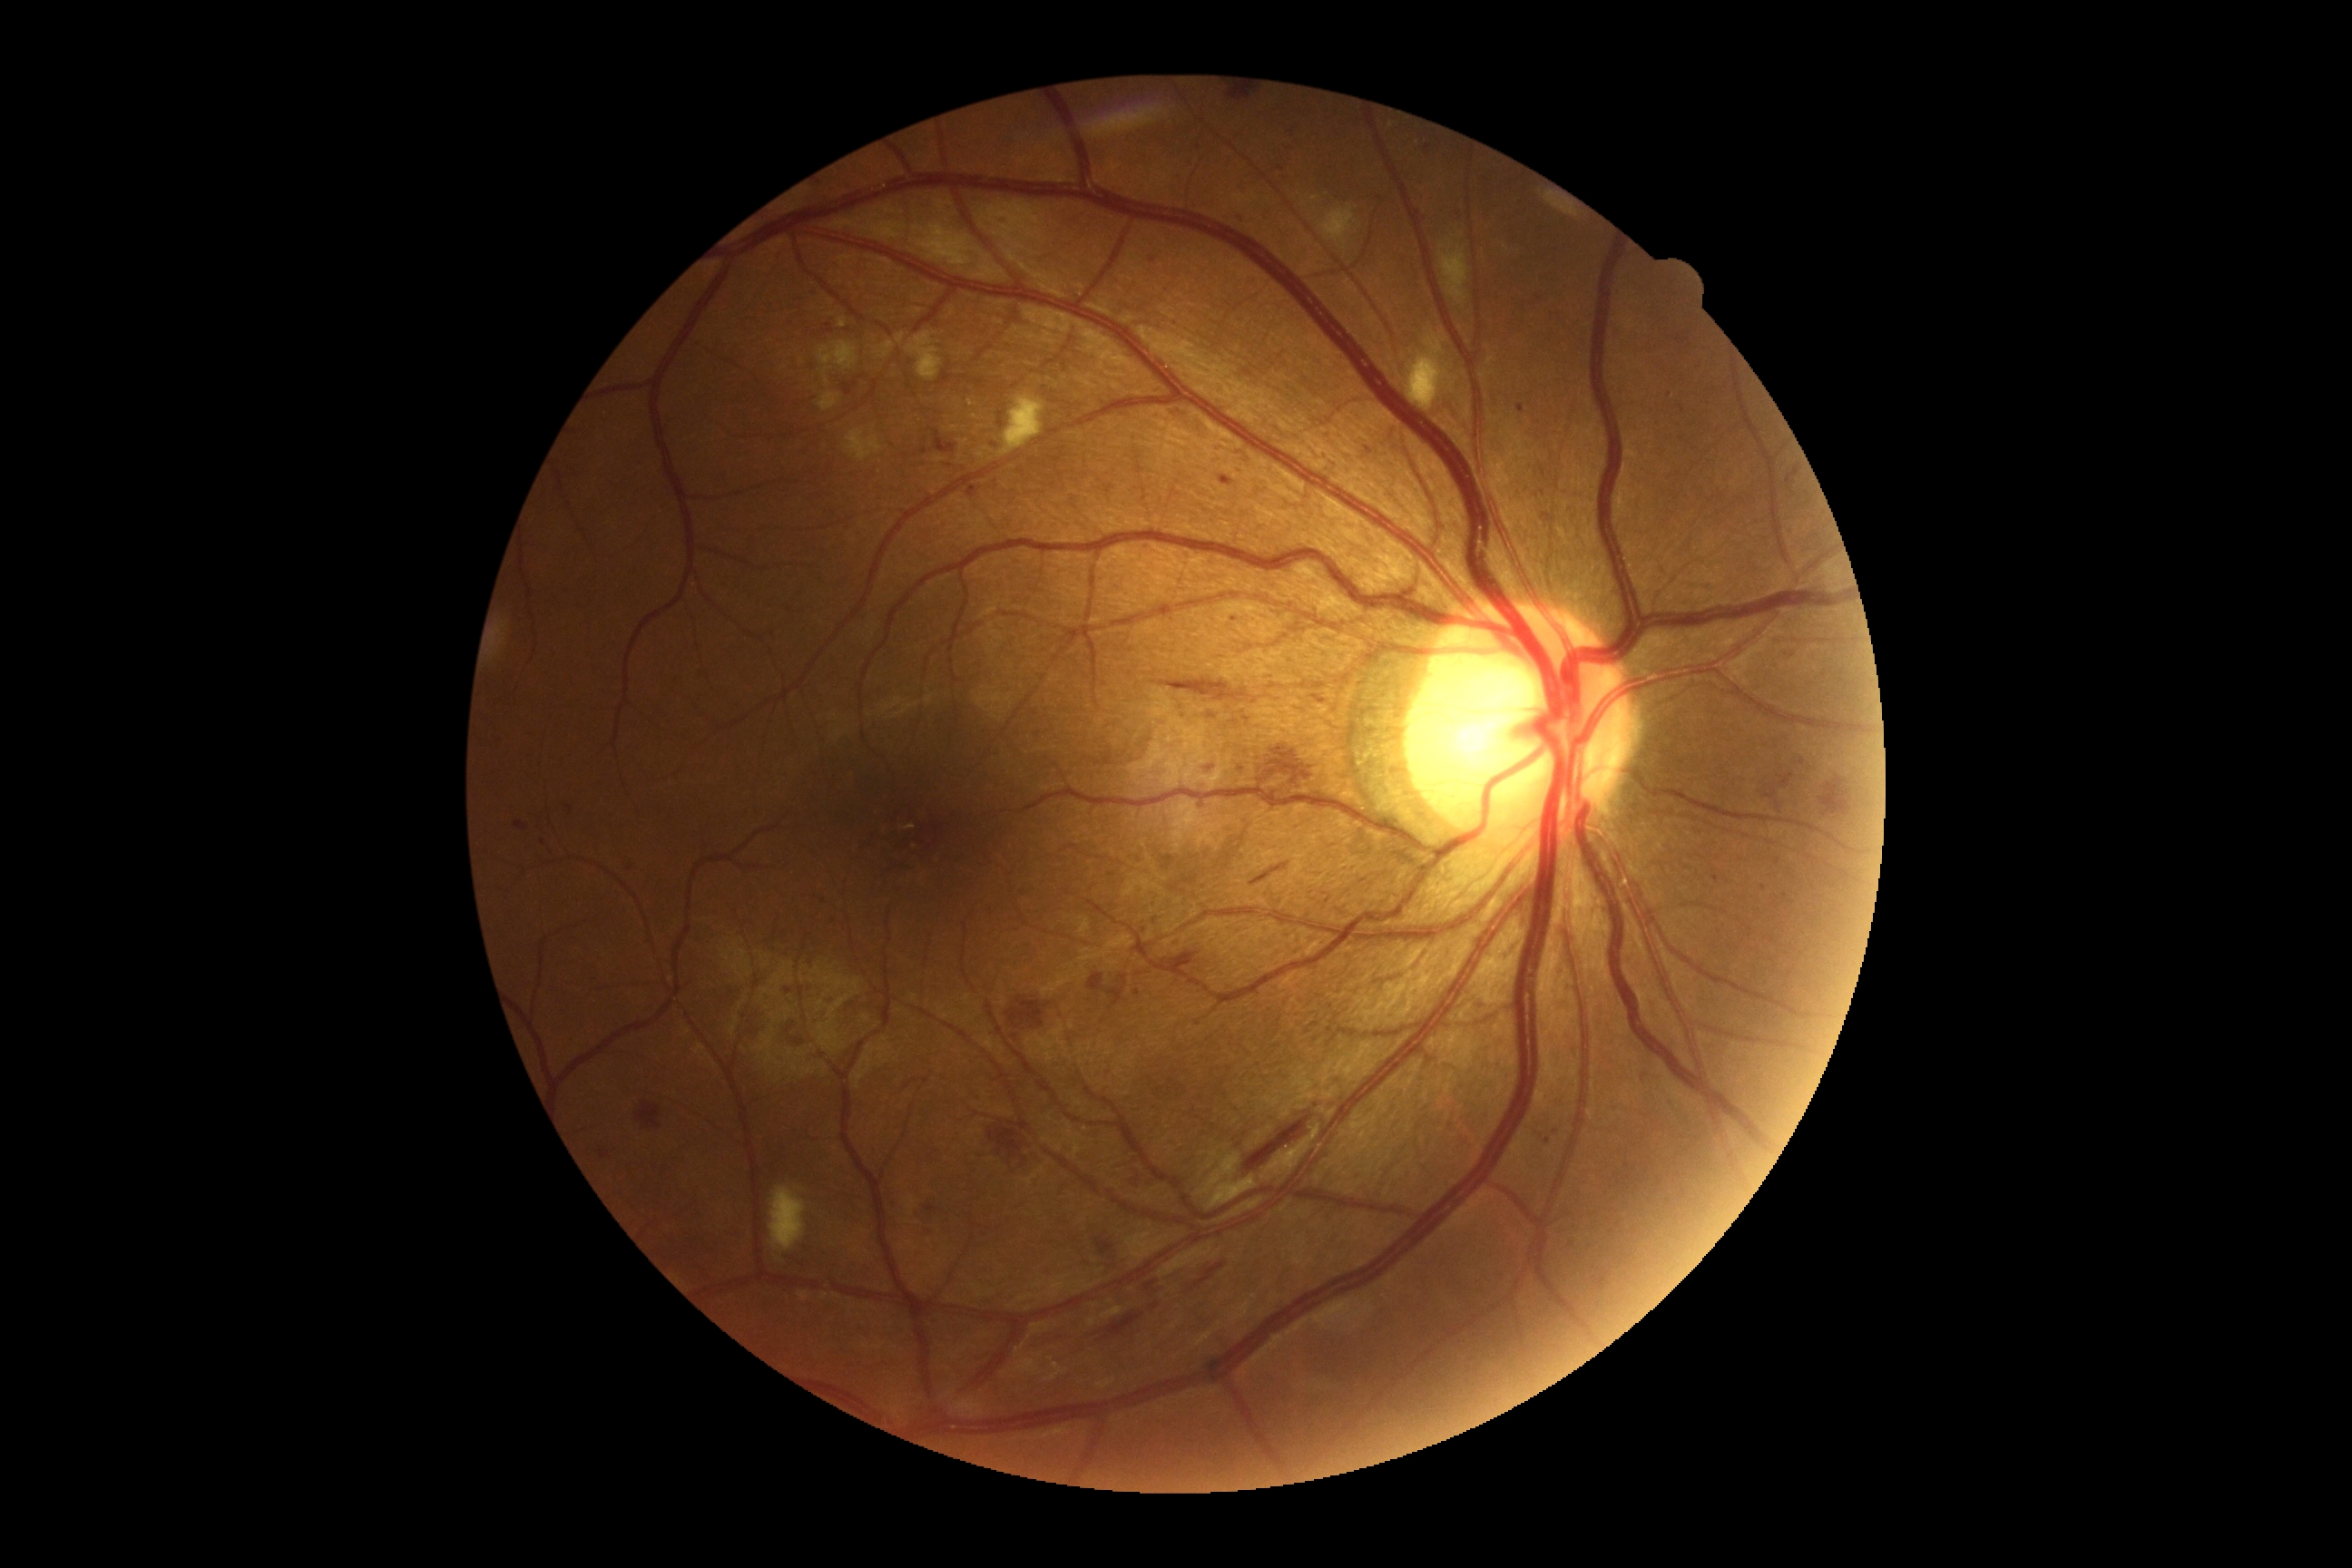
DR: 2.